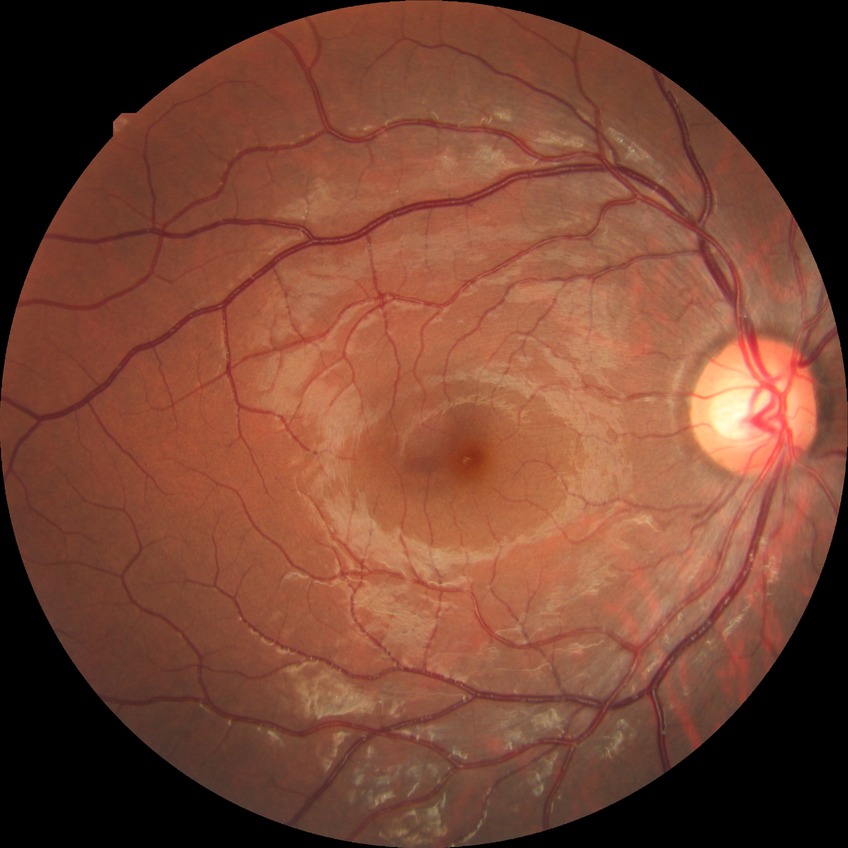
Diabetic retinopathy (DR): NDR (no diabetic retinopathy).